45° FOV. 2212 x 1659 pixels — 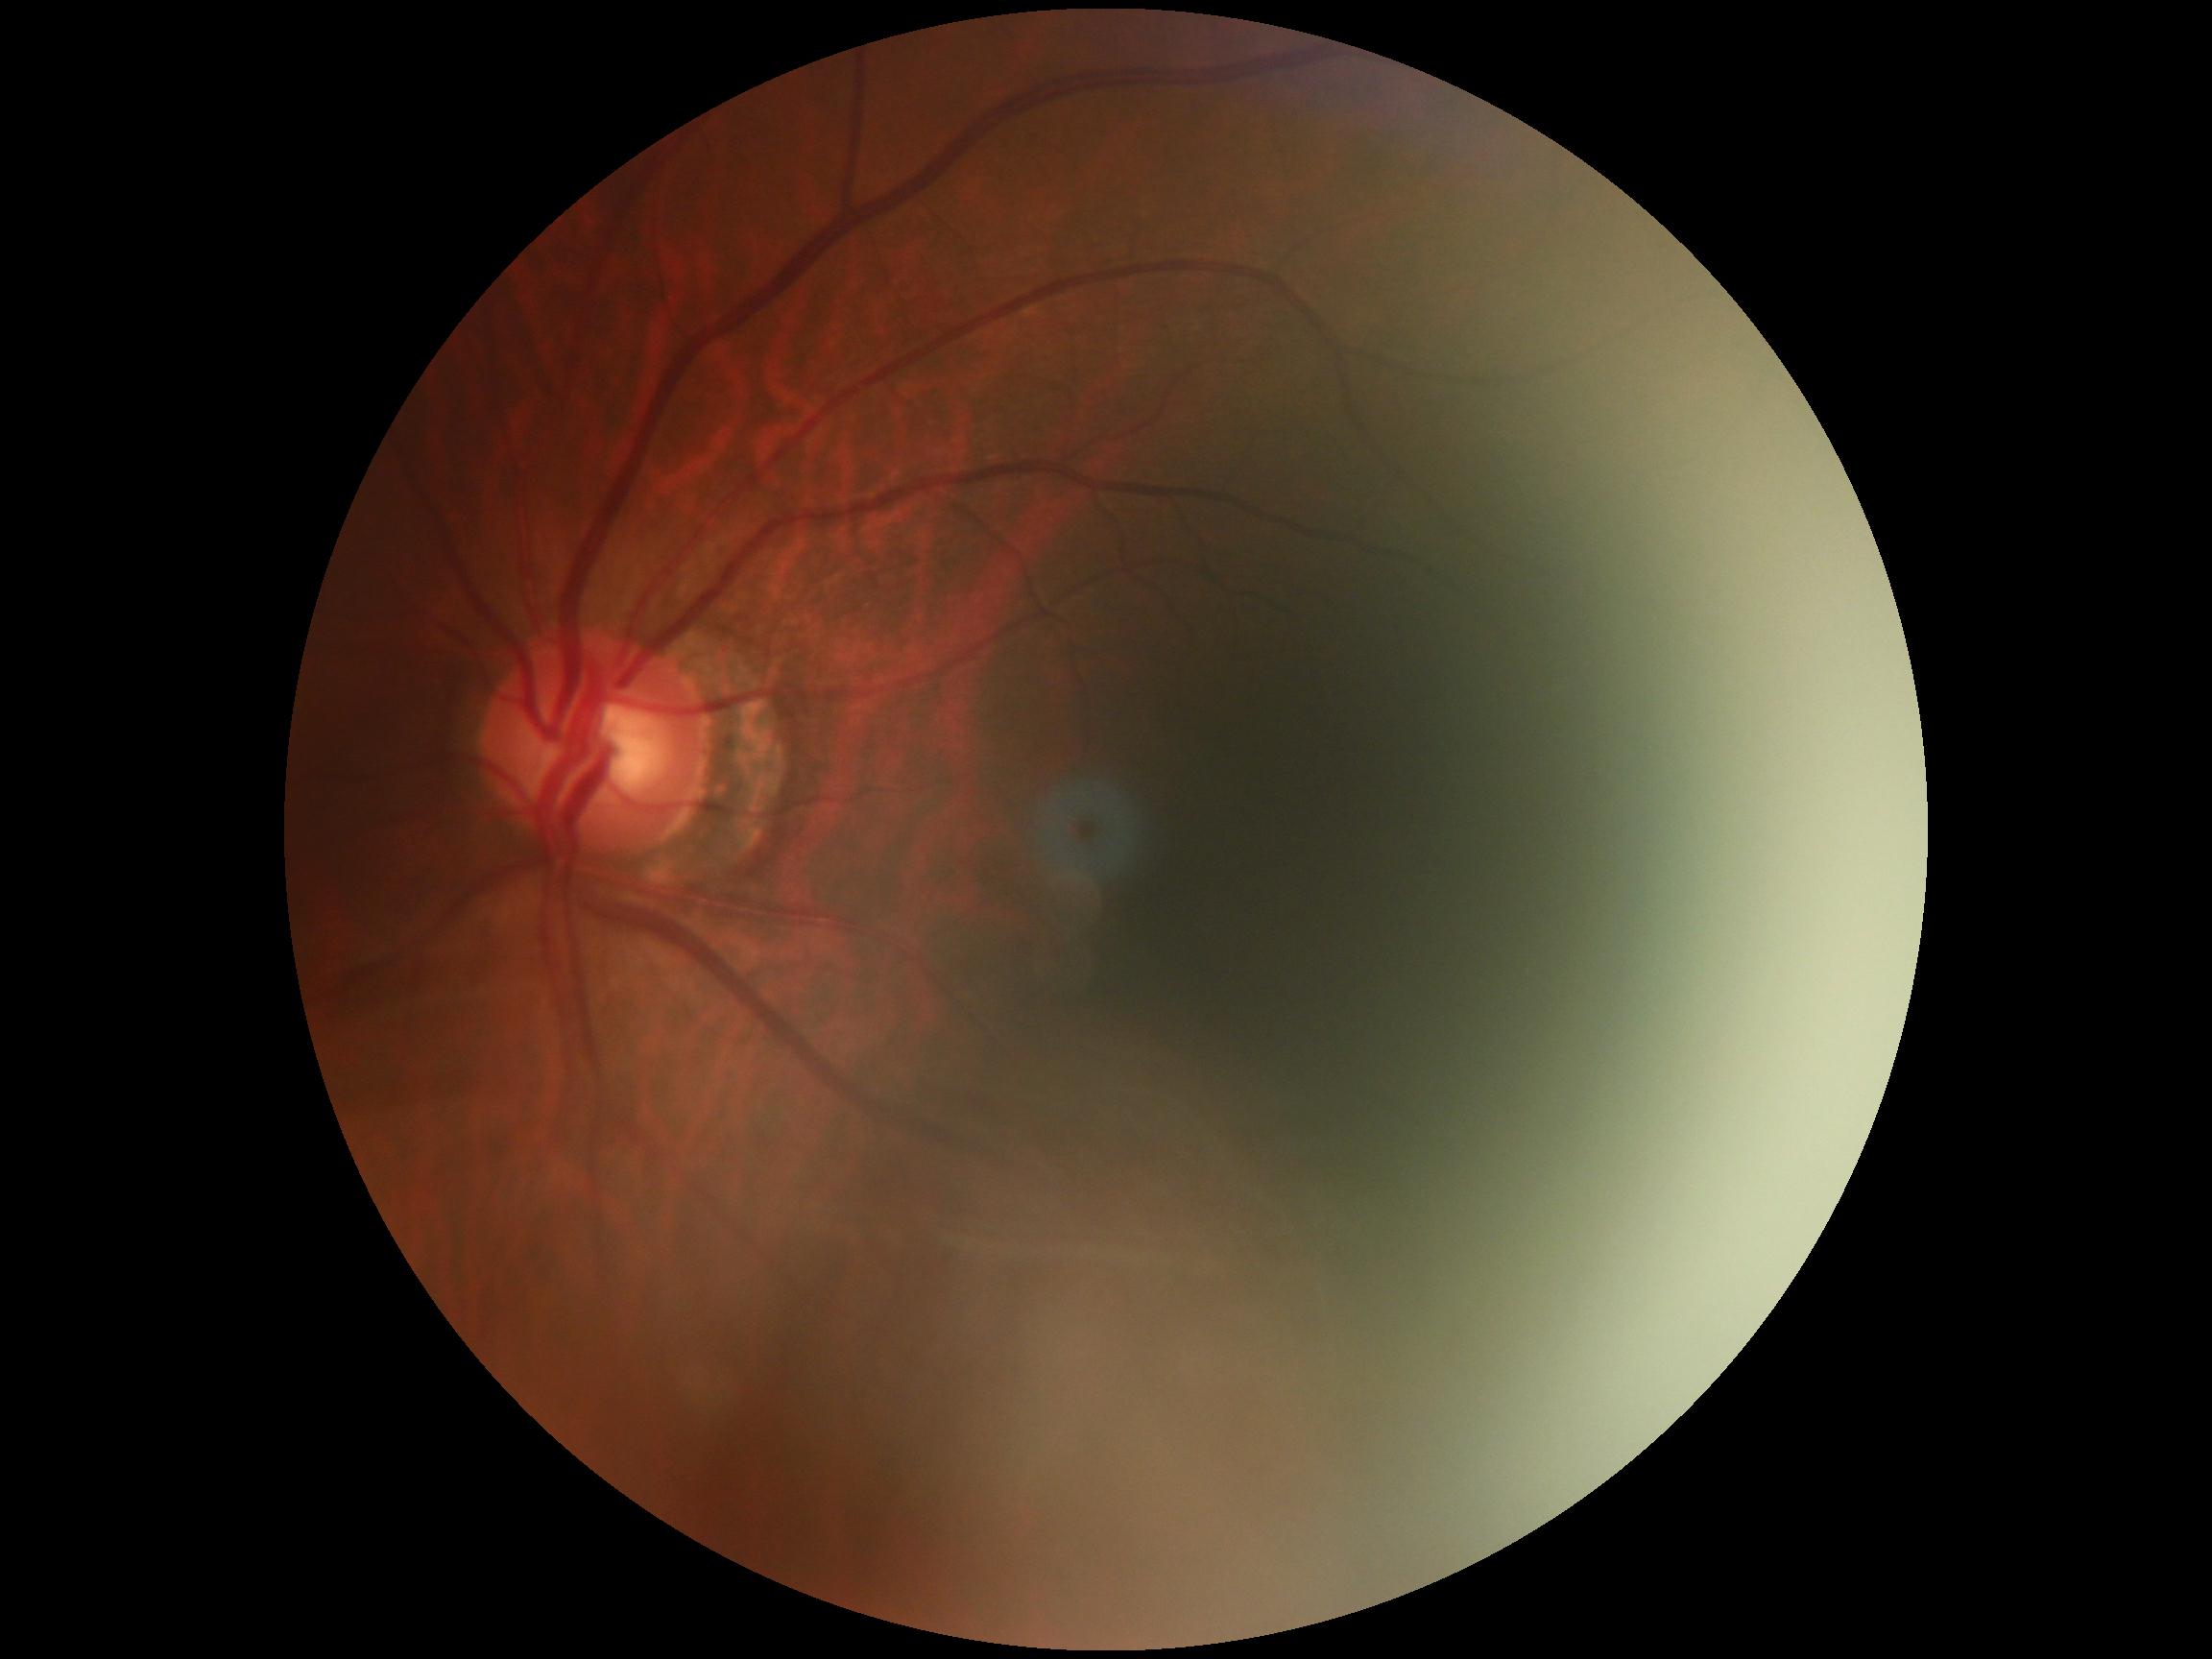 Findings:
- DR severity: 0/4